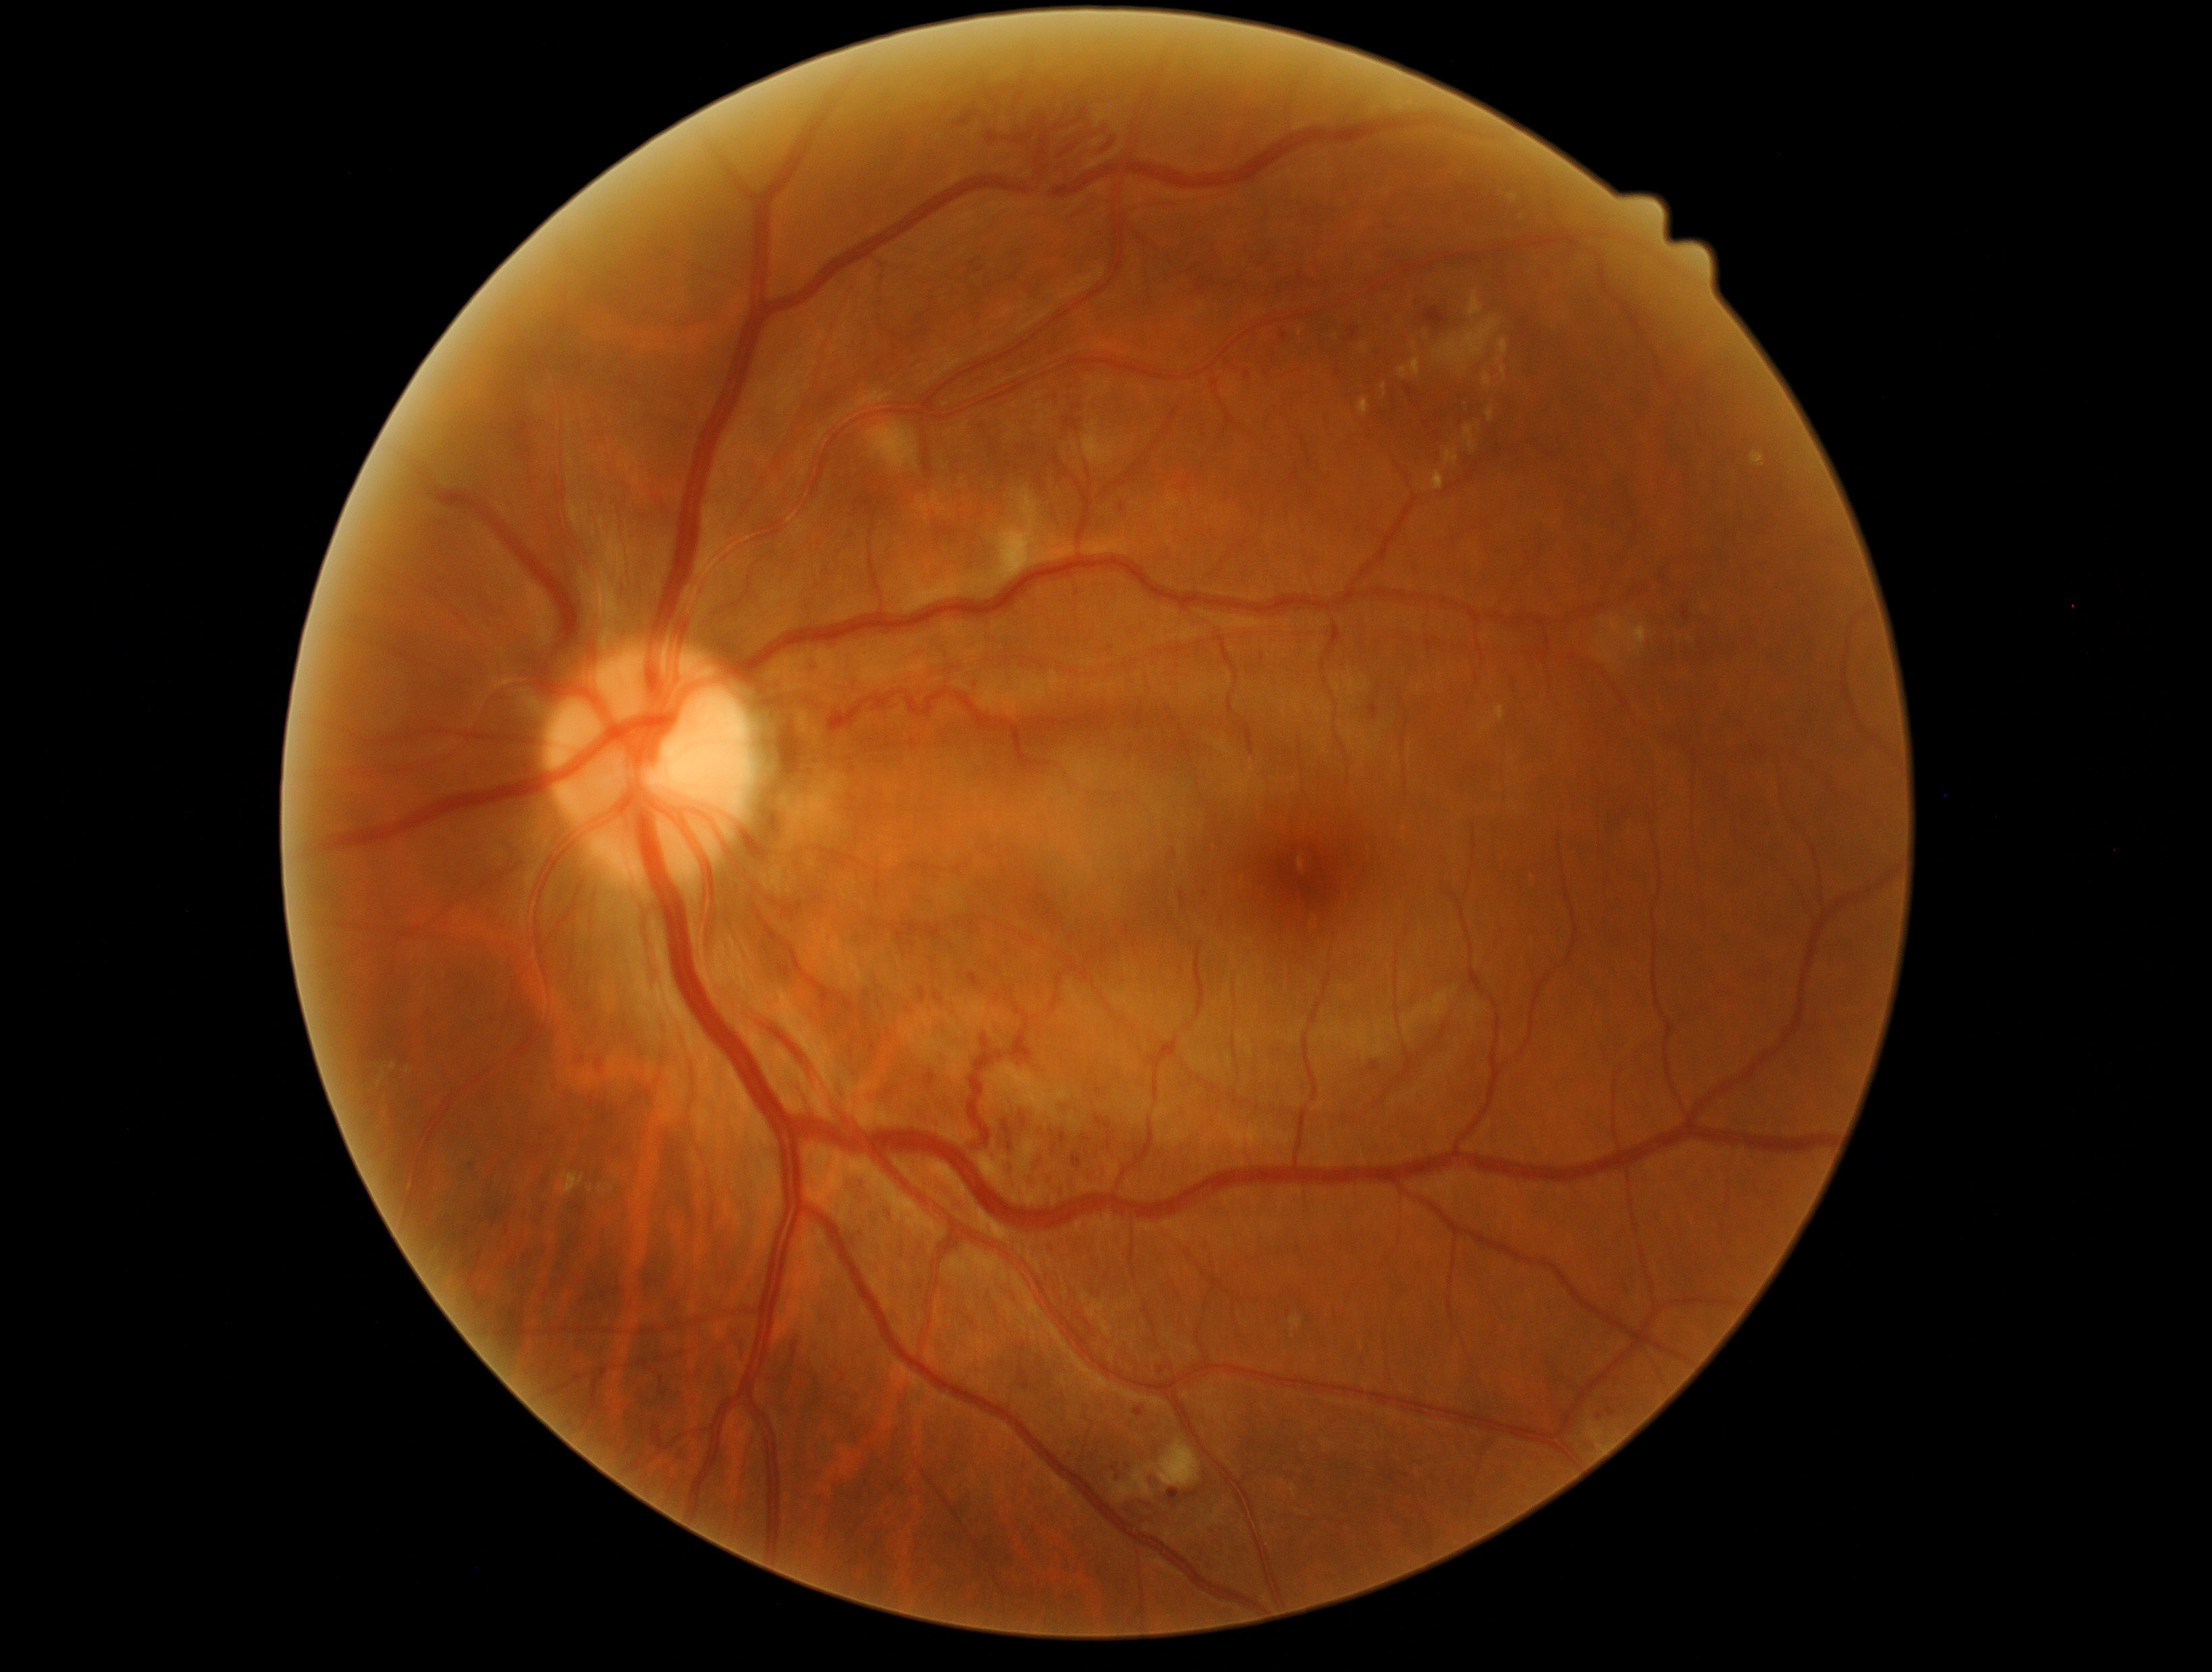

diabetic retinopathy (DR): 3/4.